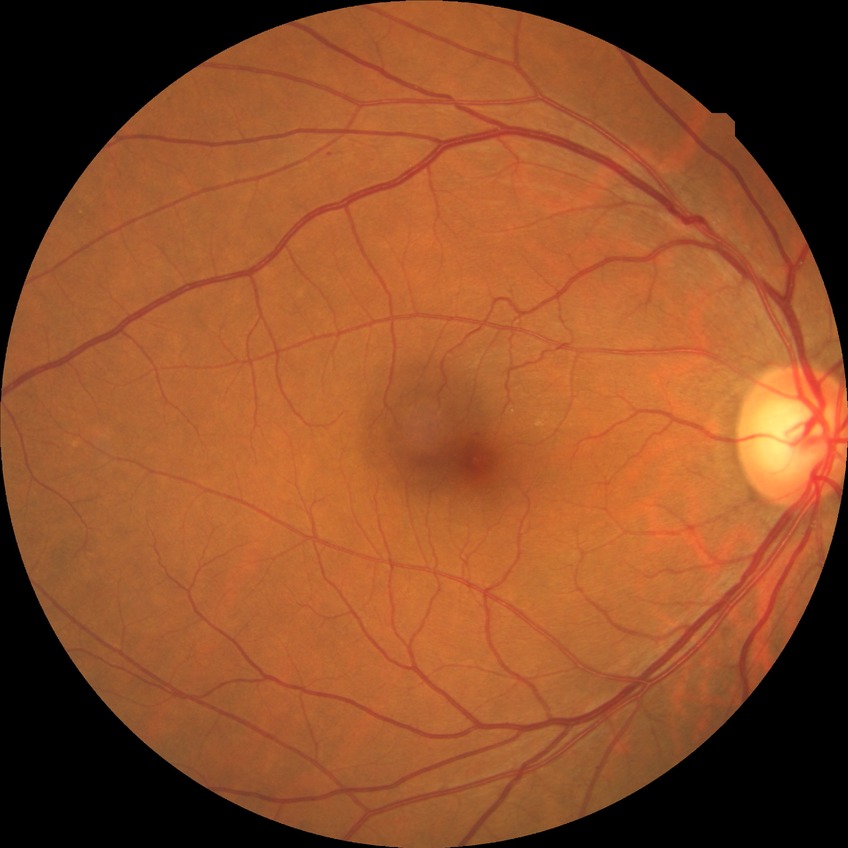

retinopathy stage = simple diabetic retinopathy | DR class = non-proliferative diabetic retinopathy.